Graded on the modified Davis scale; nonmydriatic fundus photograph:
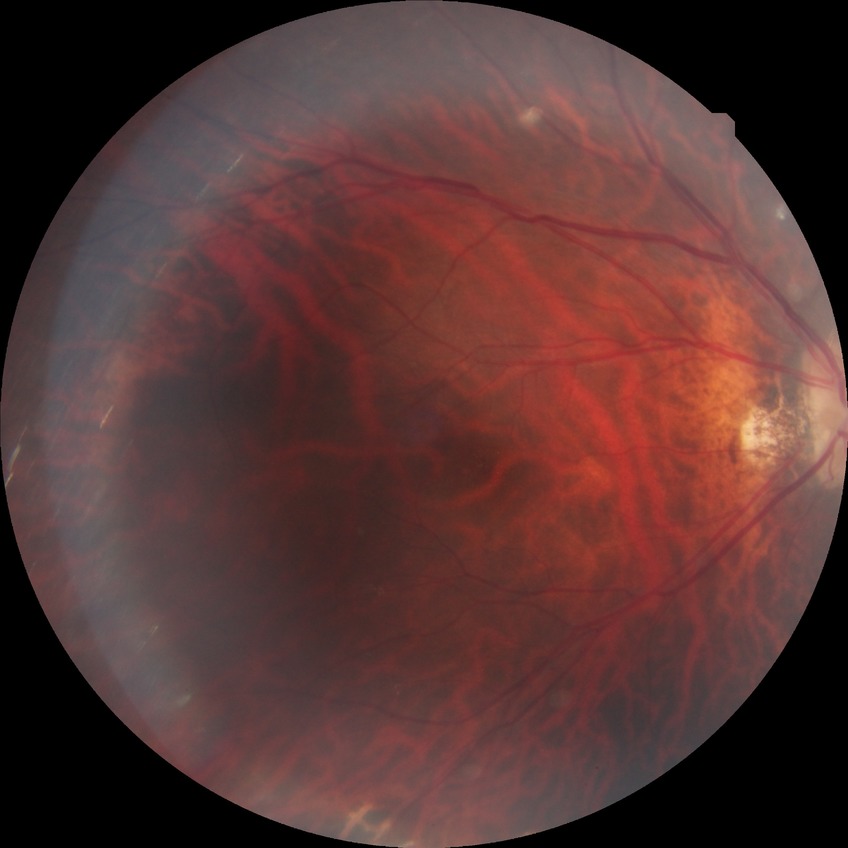 No DR findings. Modified Davis grade is NDR.